45° FOV, fundus photo, image size 2352x1568 — 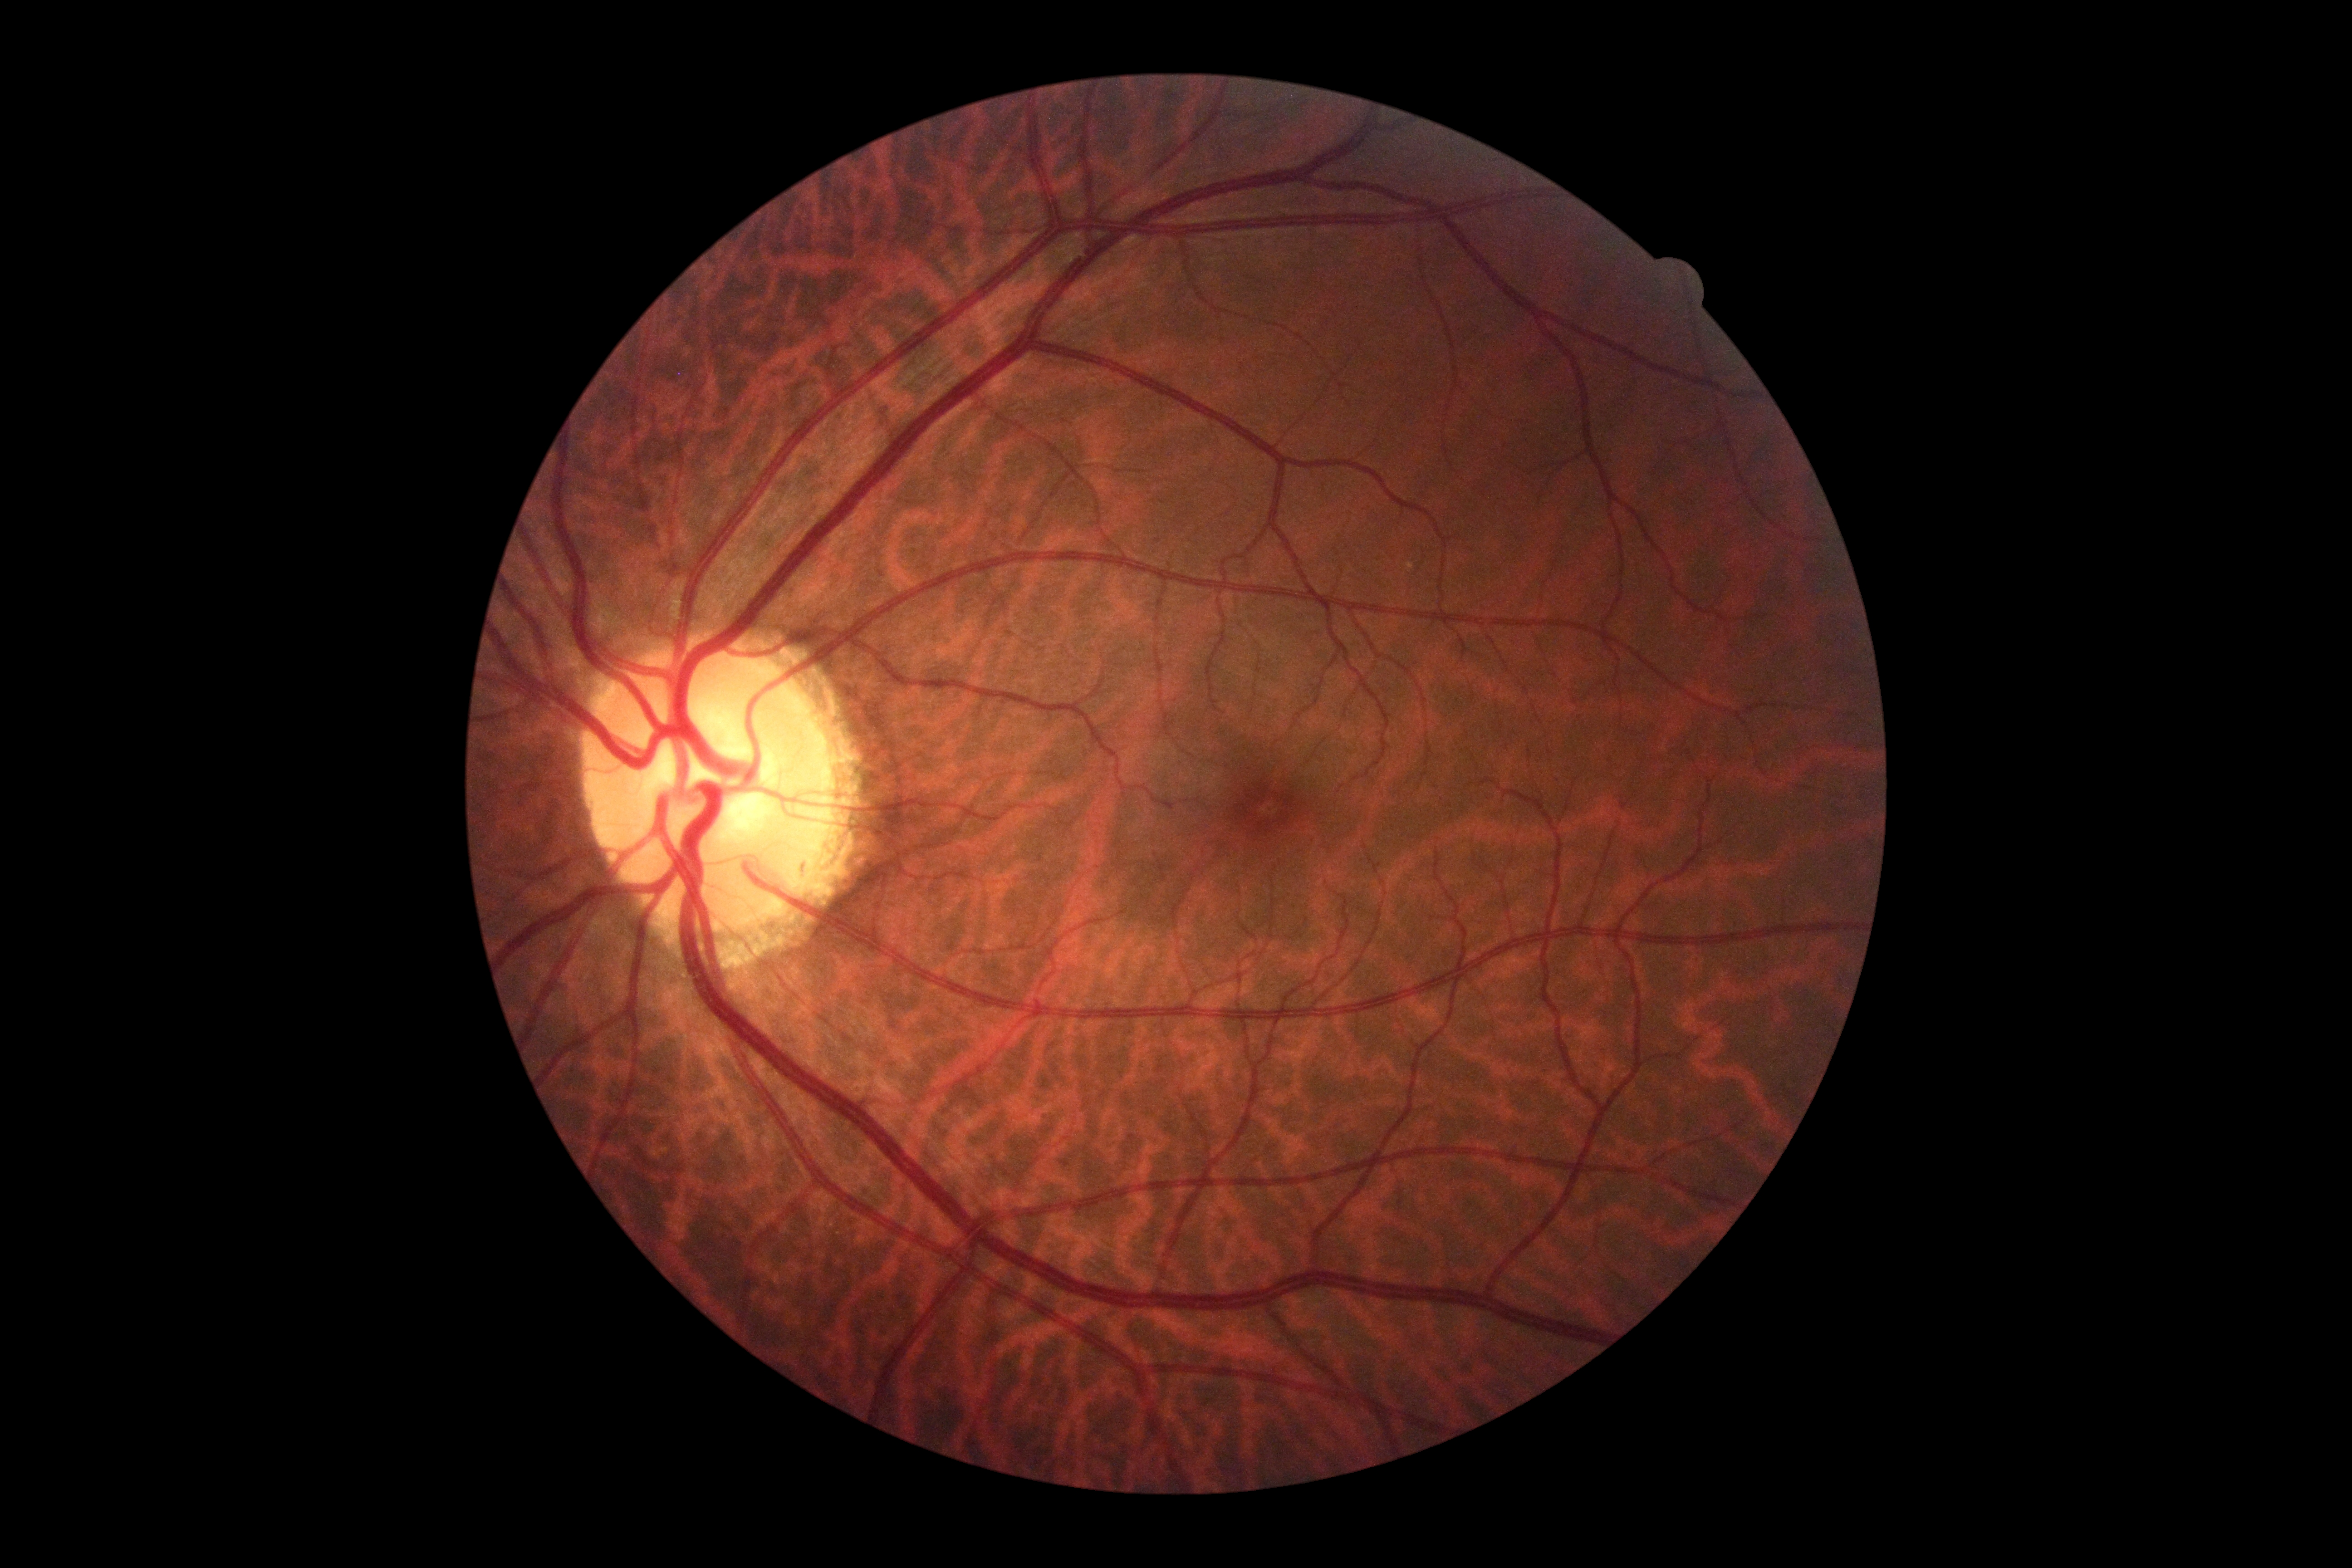
  dr_grade: 0/4 — no visible signs of diabetic retinopathy